DR severity per modified Davis staging; posterior pole photograph.
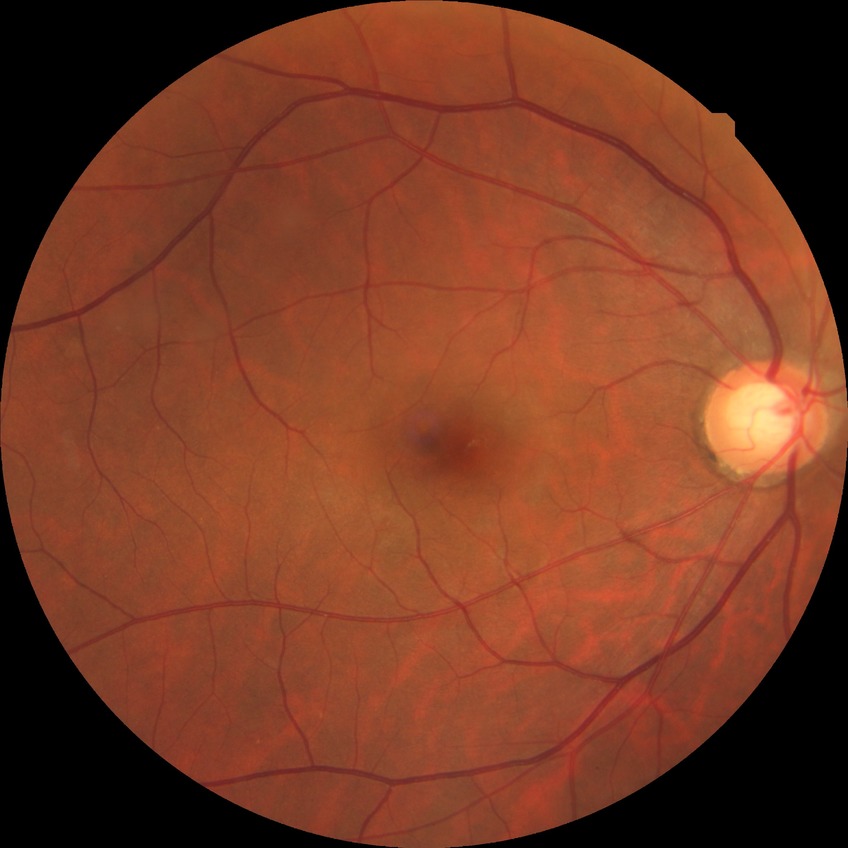
{
  "davis_grade": "NDR (no diabetic retinopathy)"
}